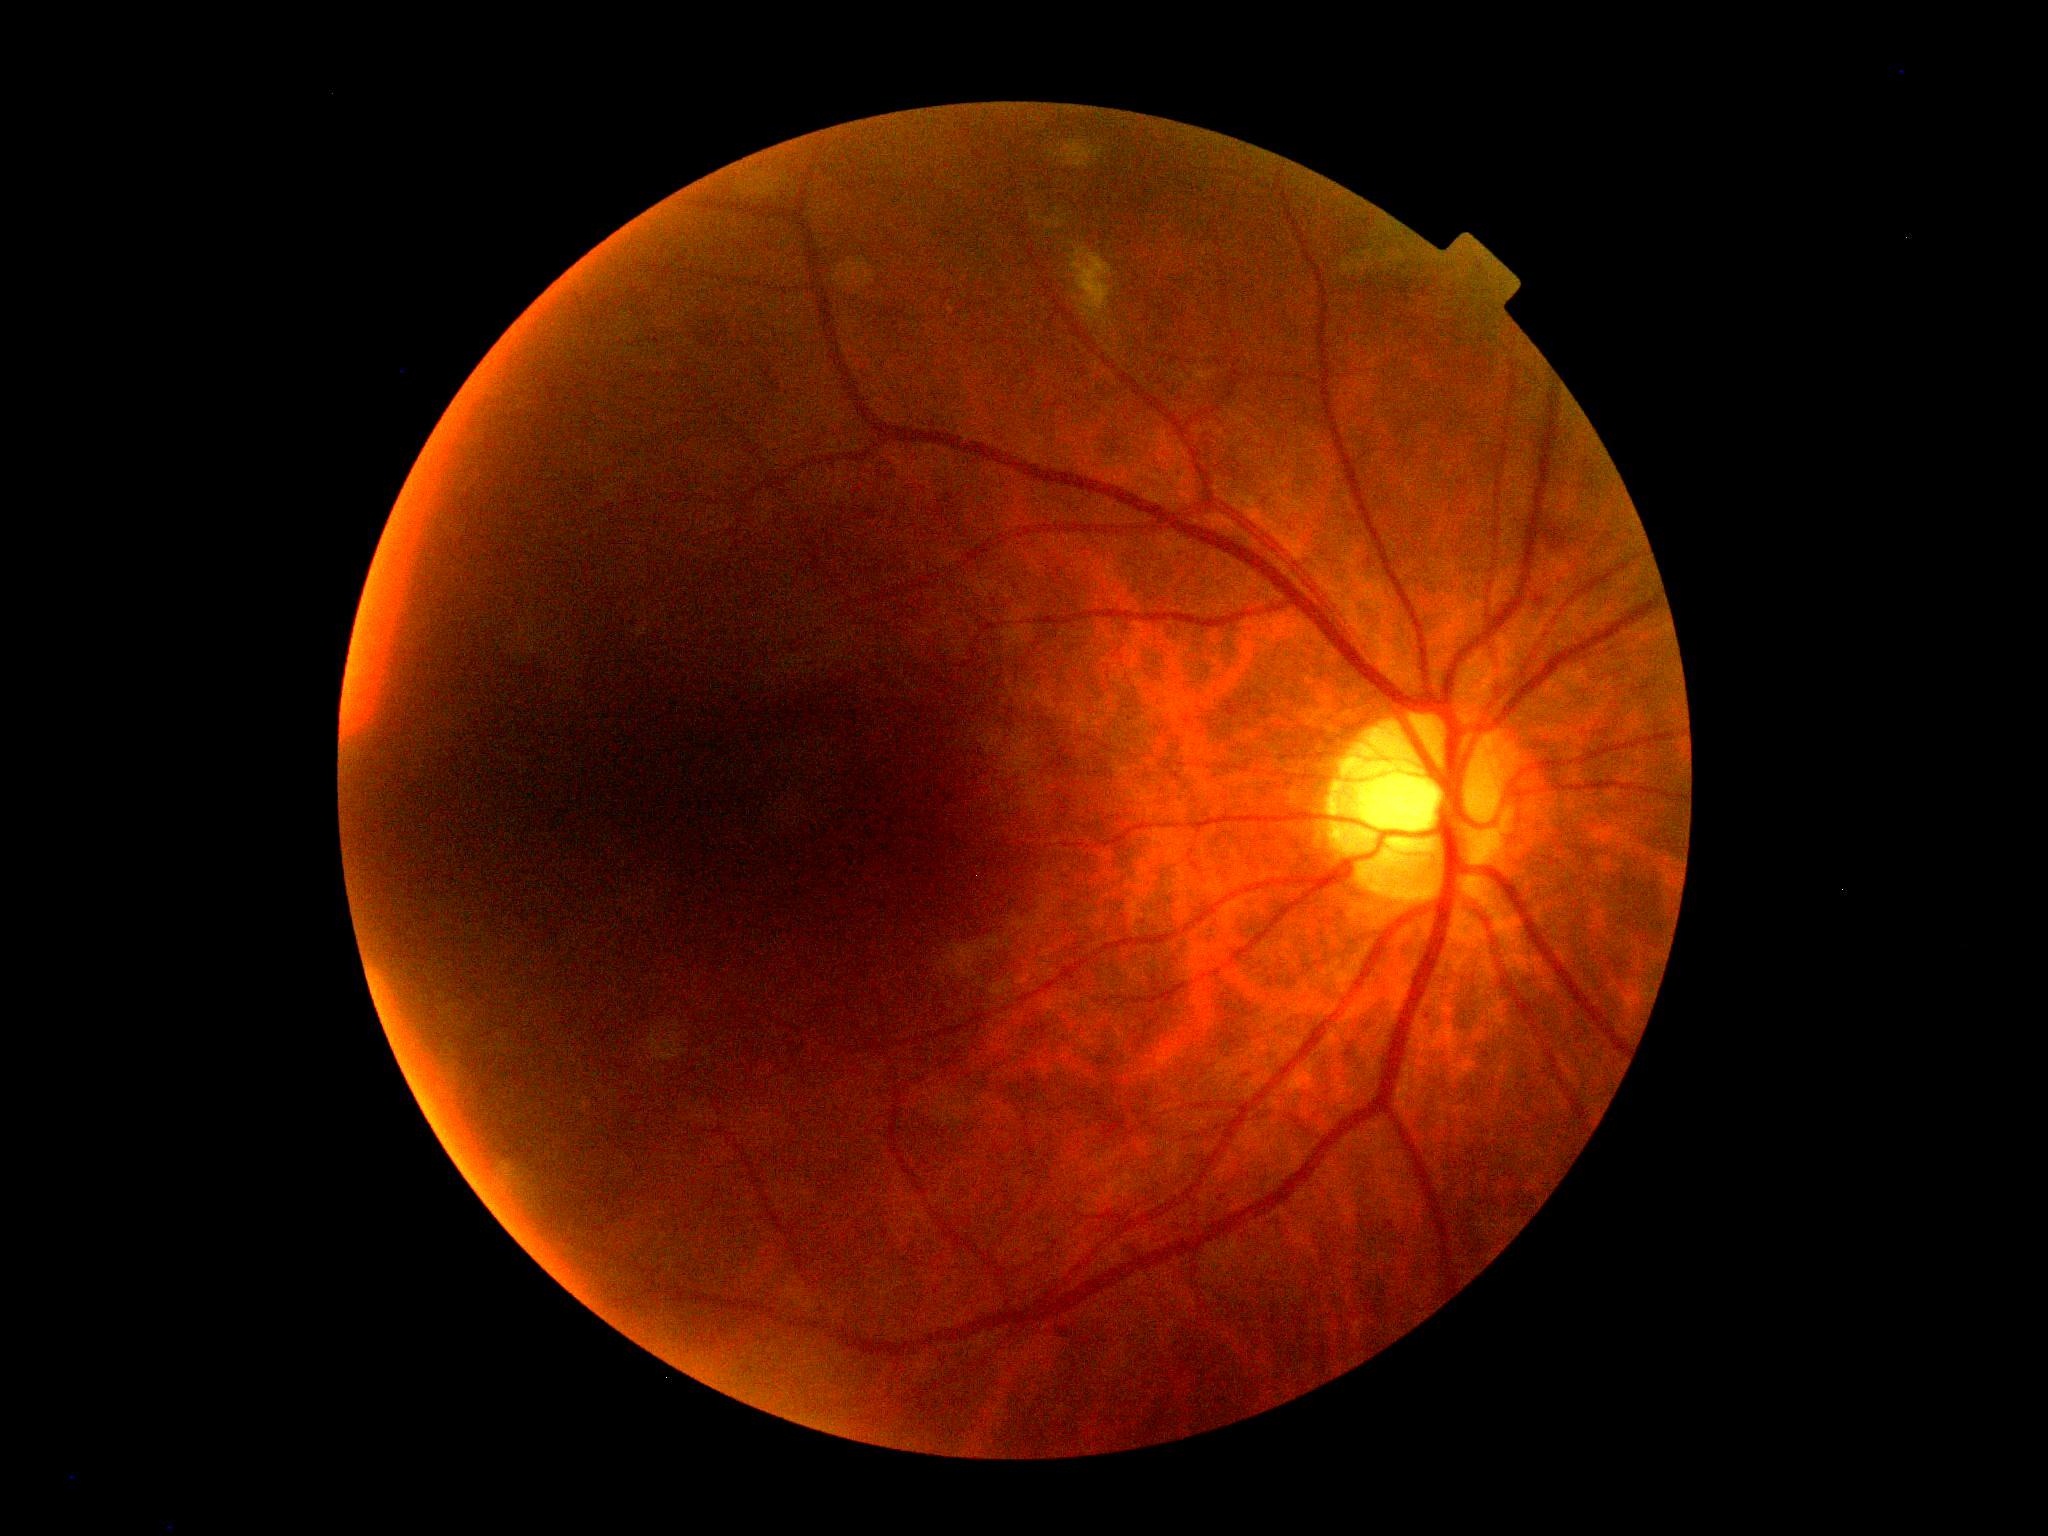 Diabetic retinopathy severity: grade 2 (moderate NPDR).